45° FOV
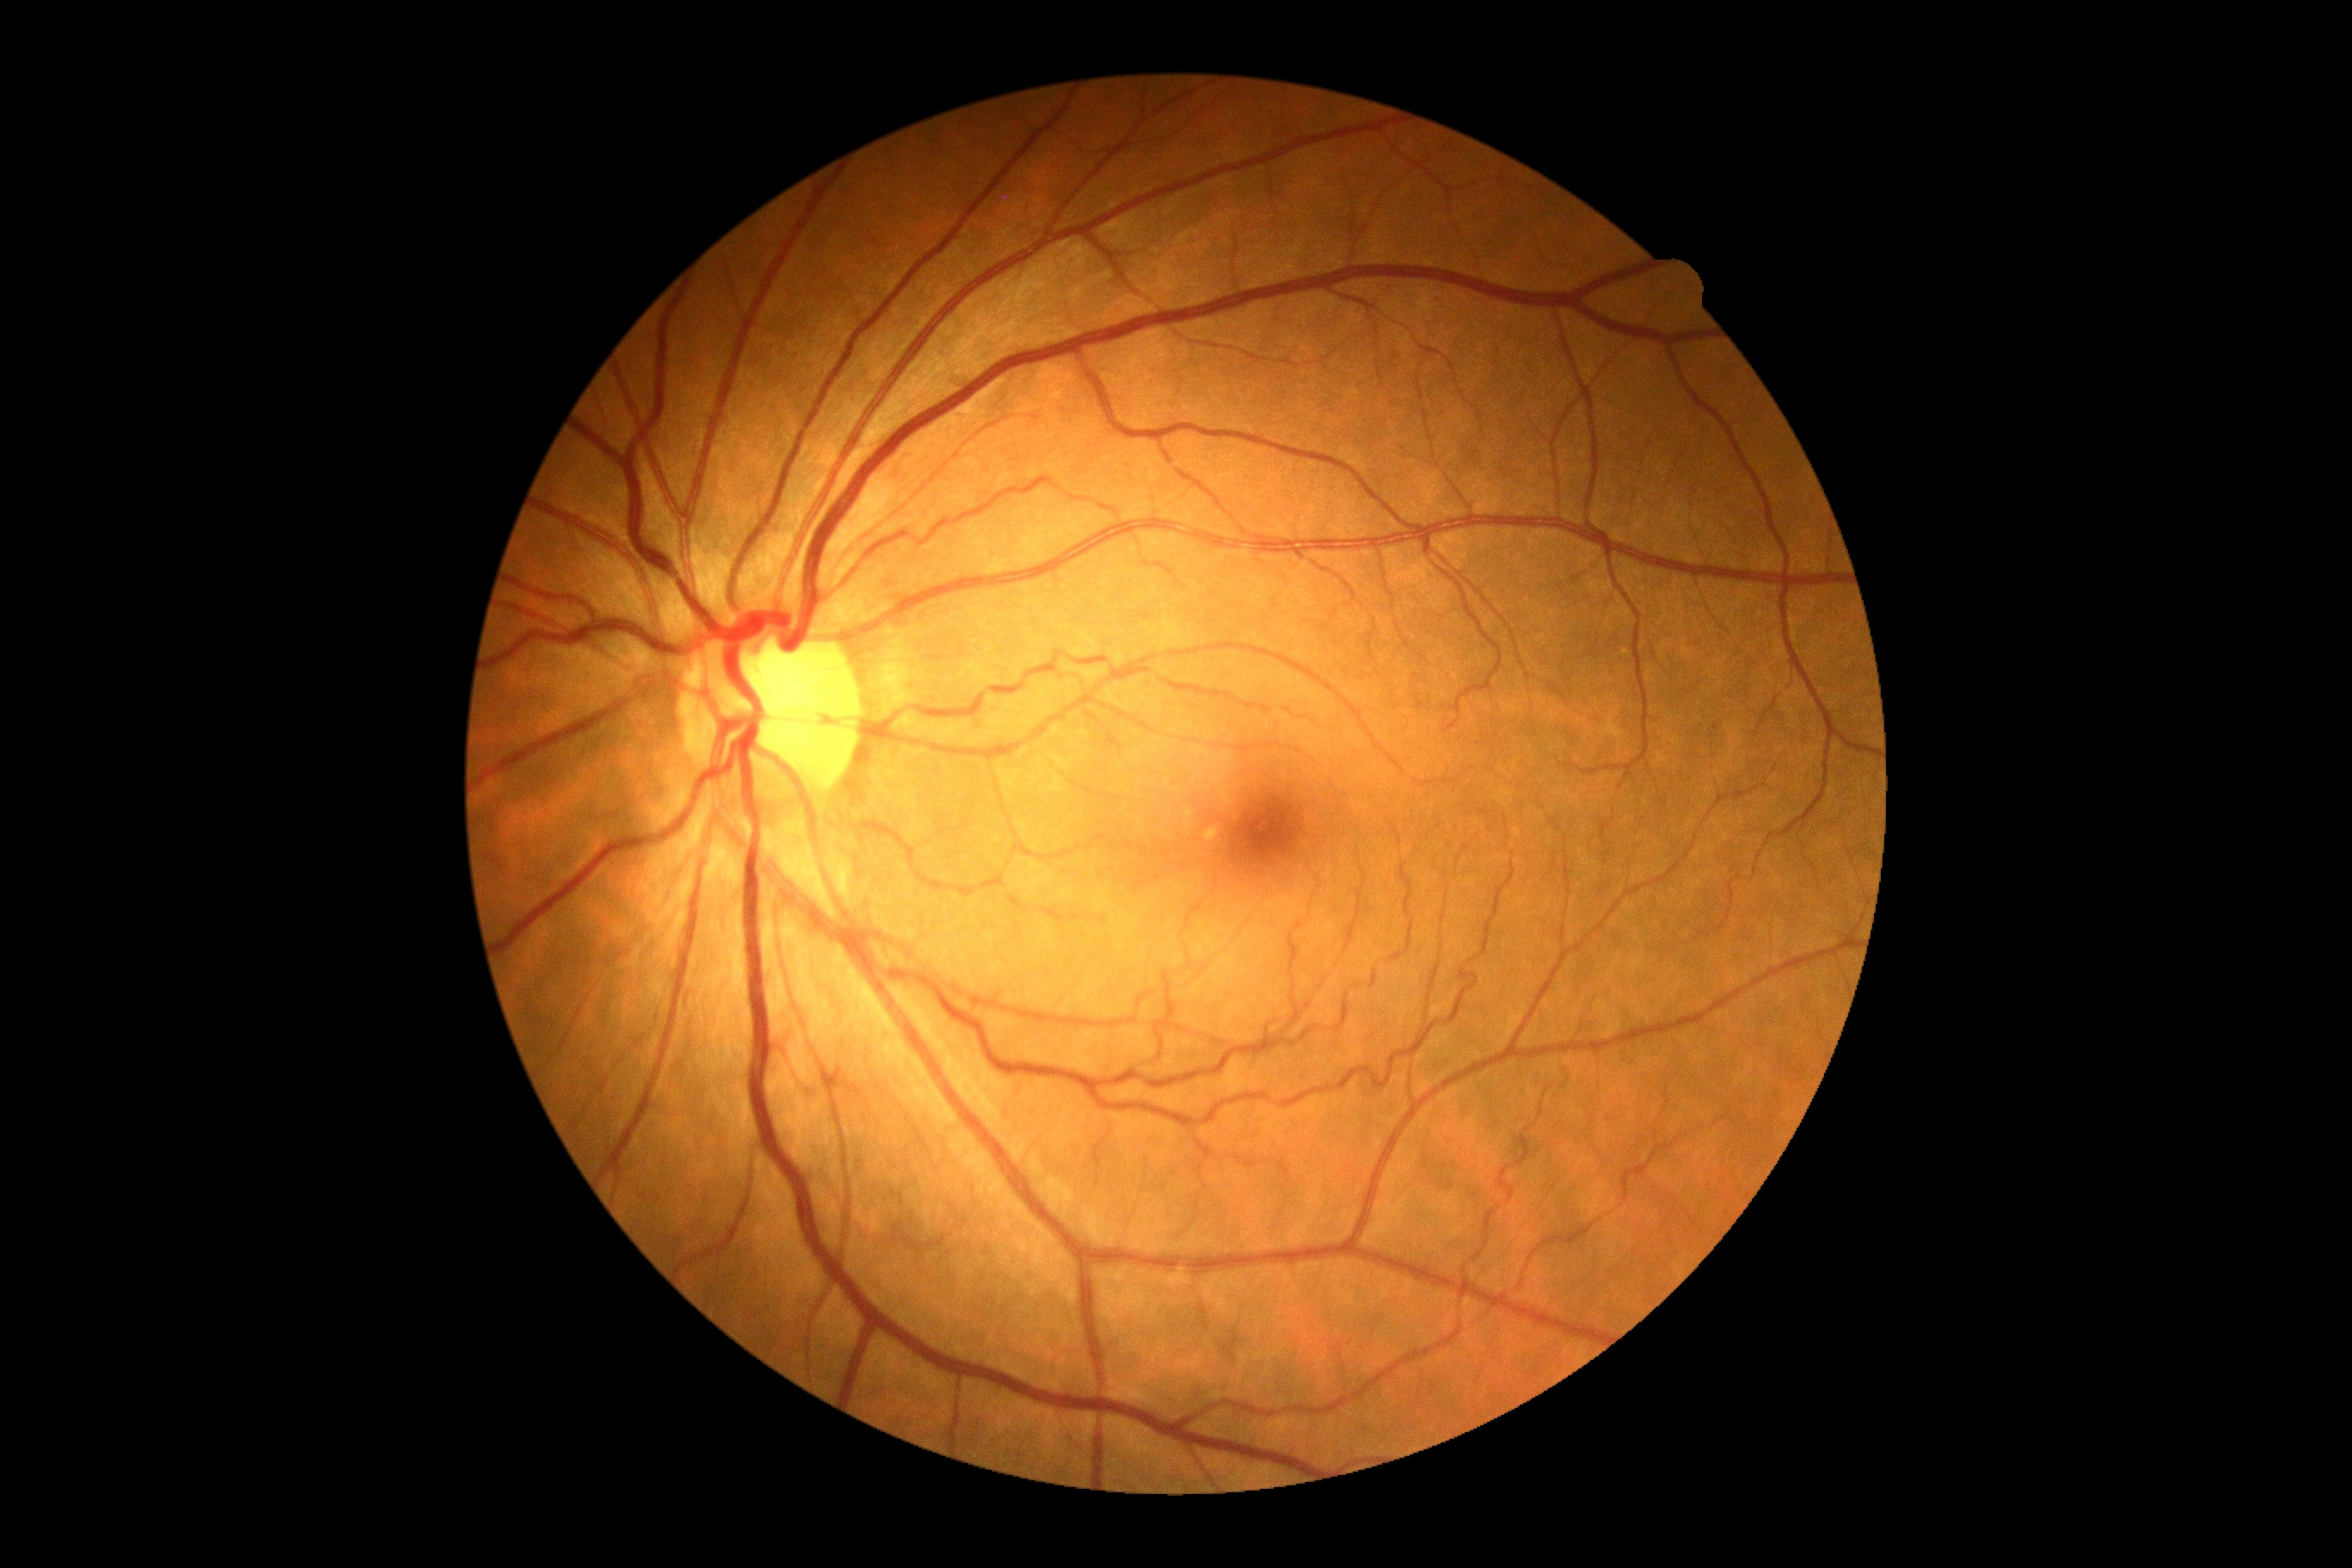 DR severity is no apparent diabetic retinopathy (grade 0). No diabetic retinal disease findings.